CFP, 2212x1659px — 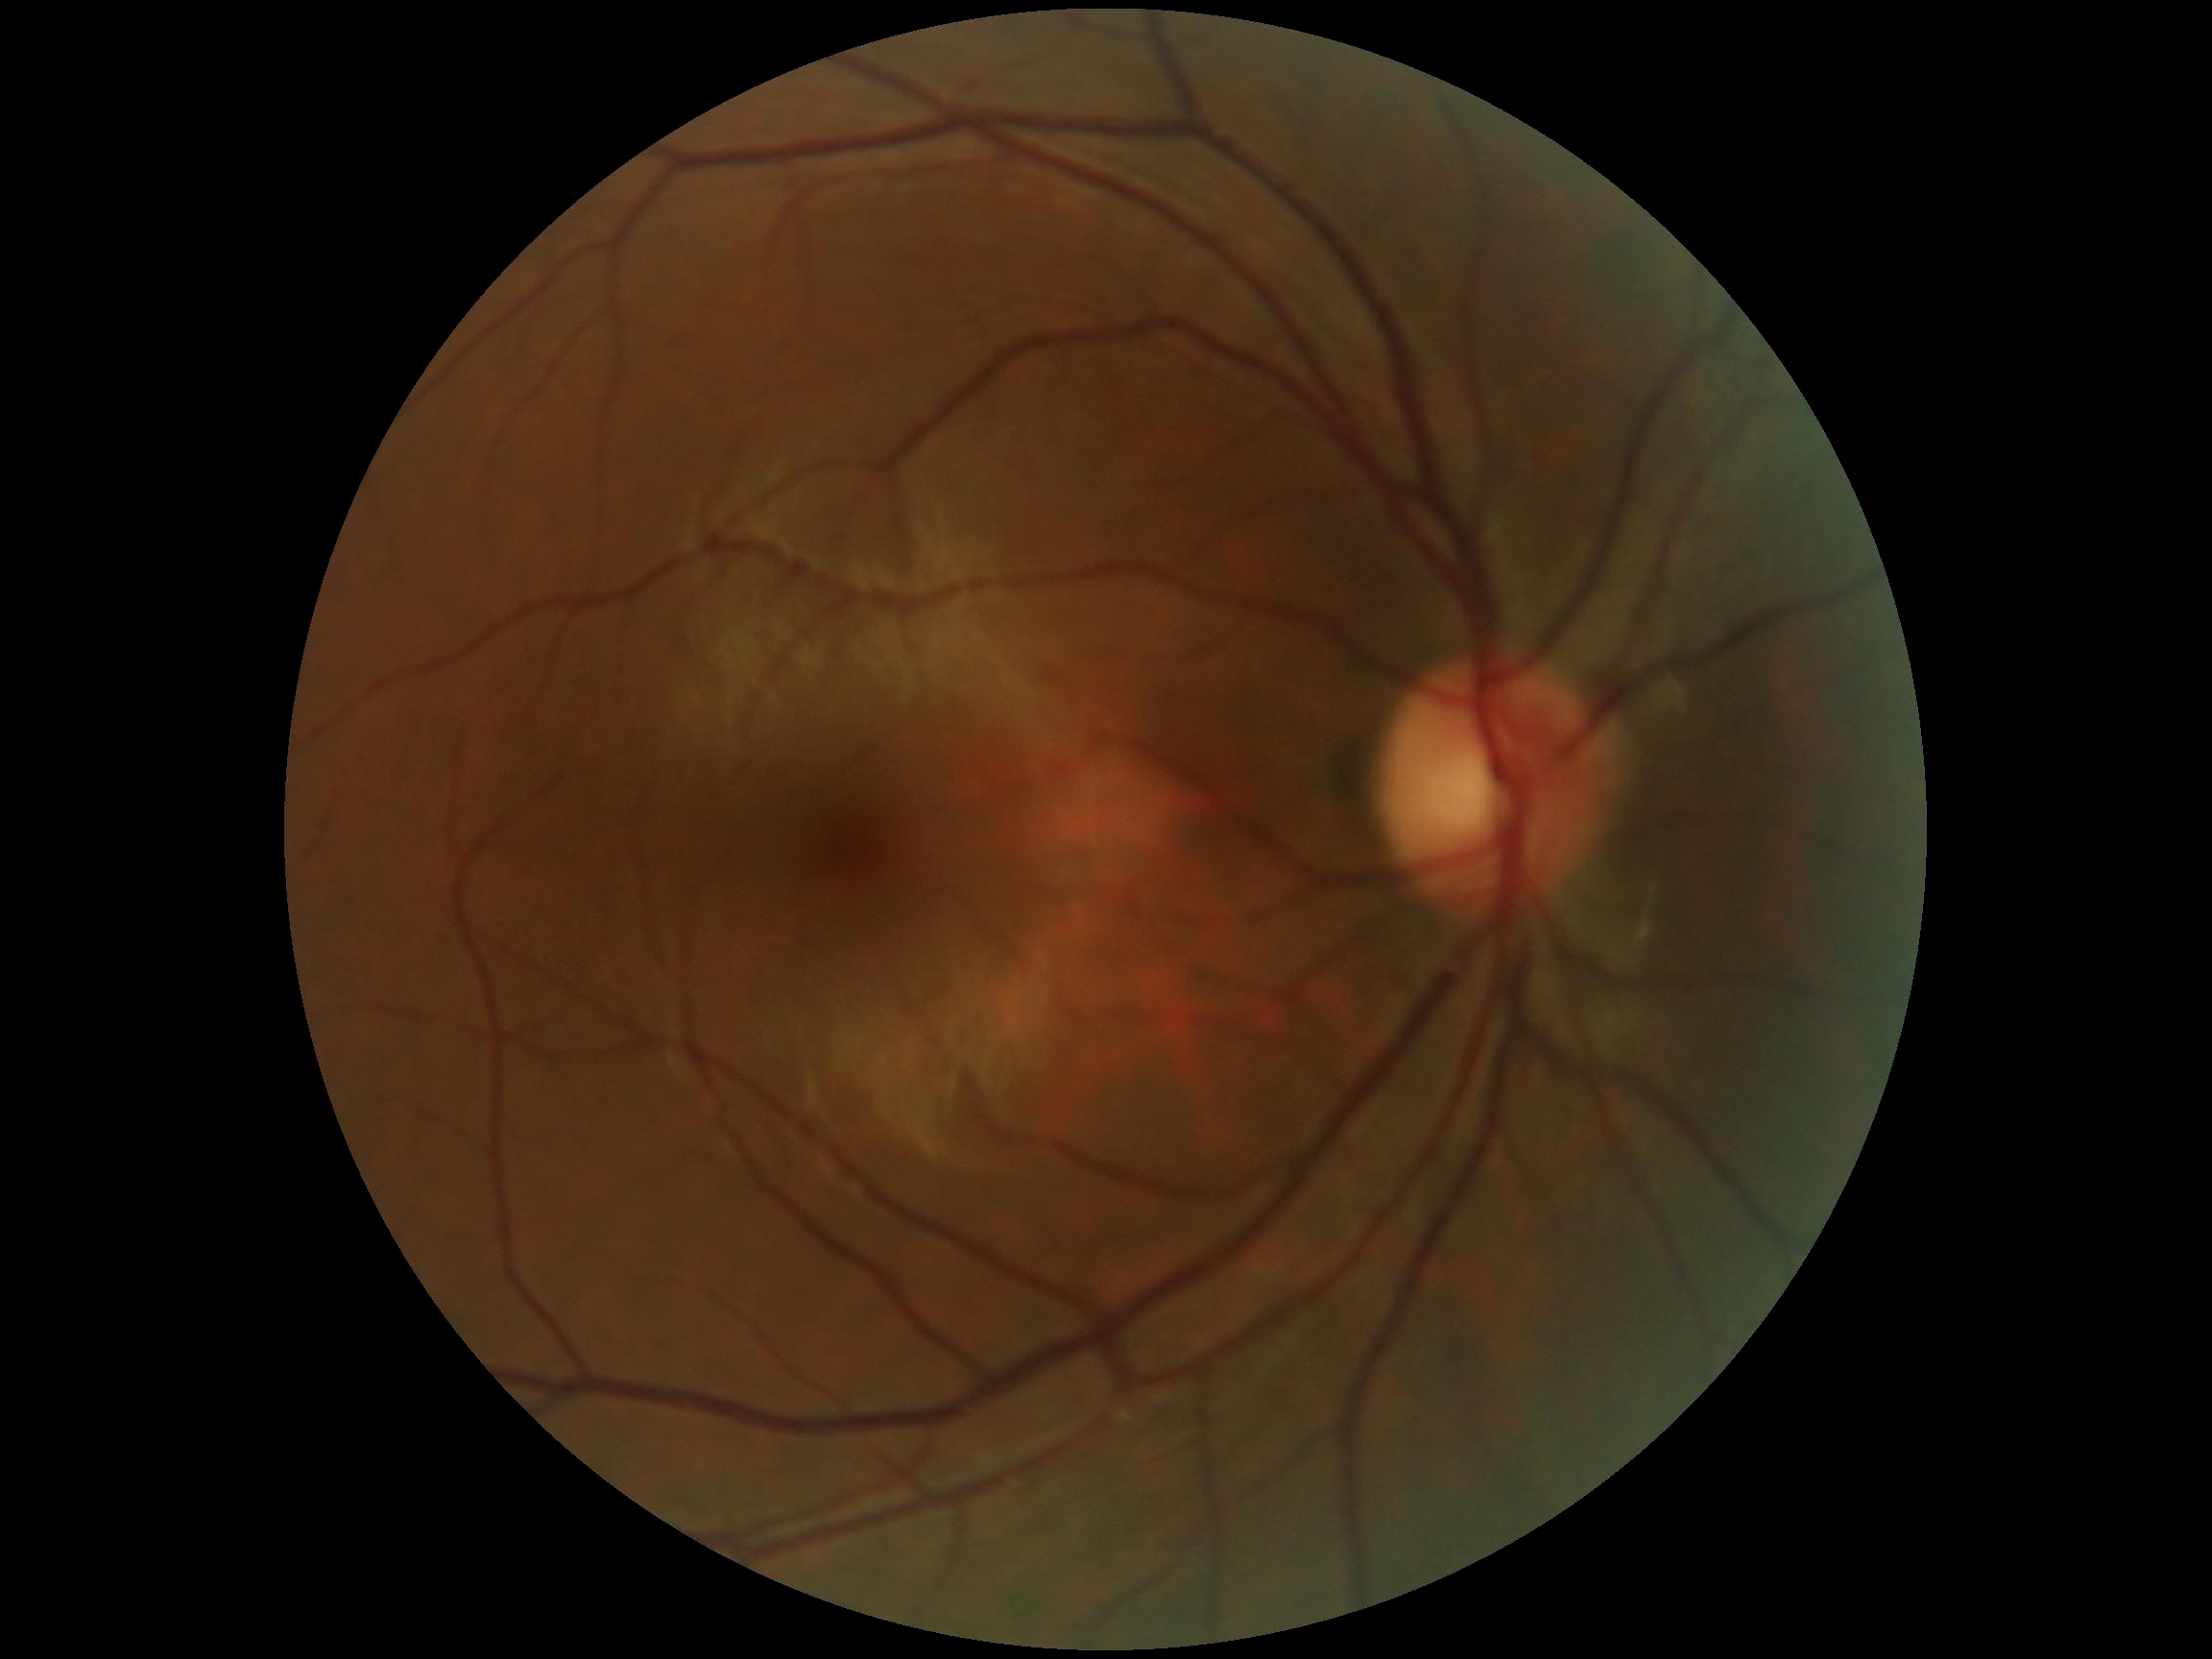

  dr_grade: no apparent diabetic retinopathy (grade 0)